45° field of view. Image size 2212x1659. Color fundus photograph — 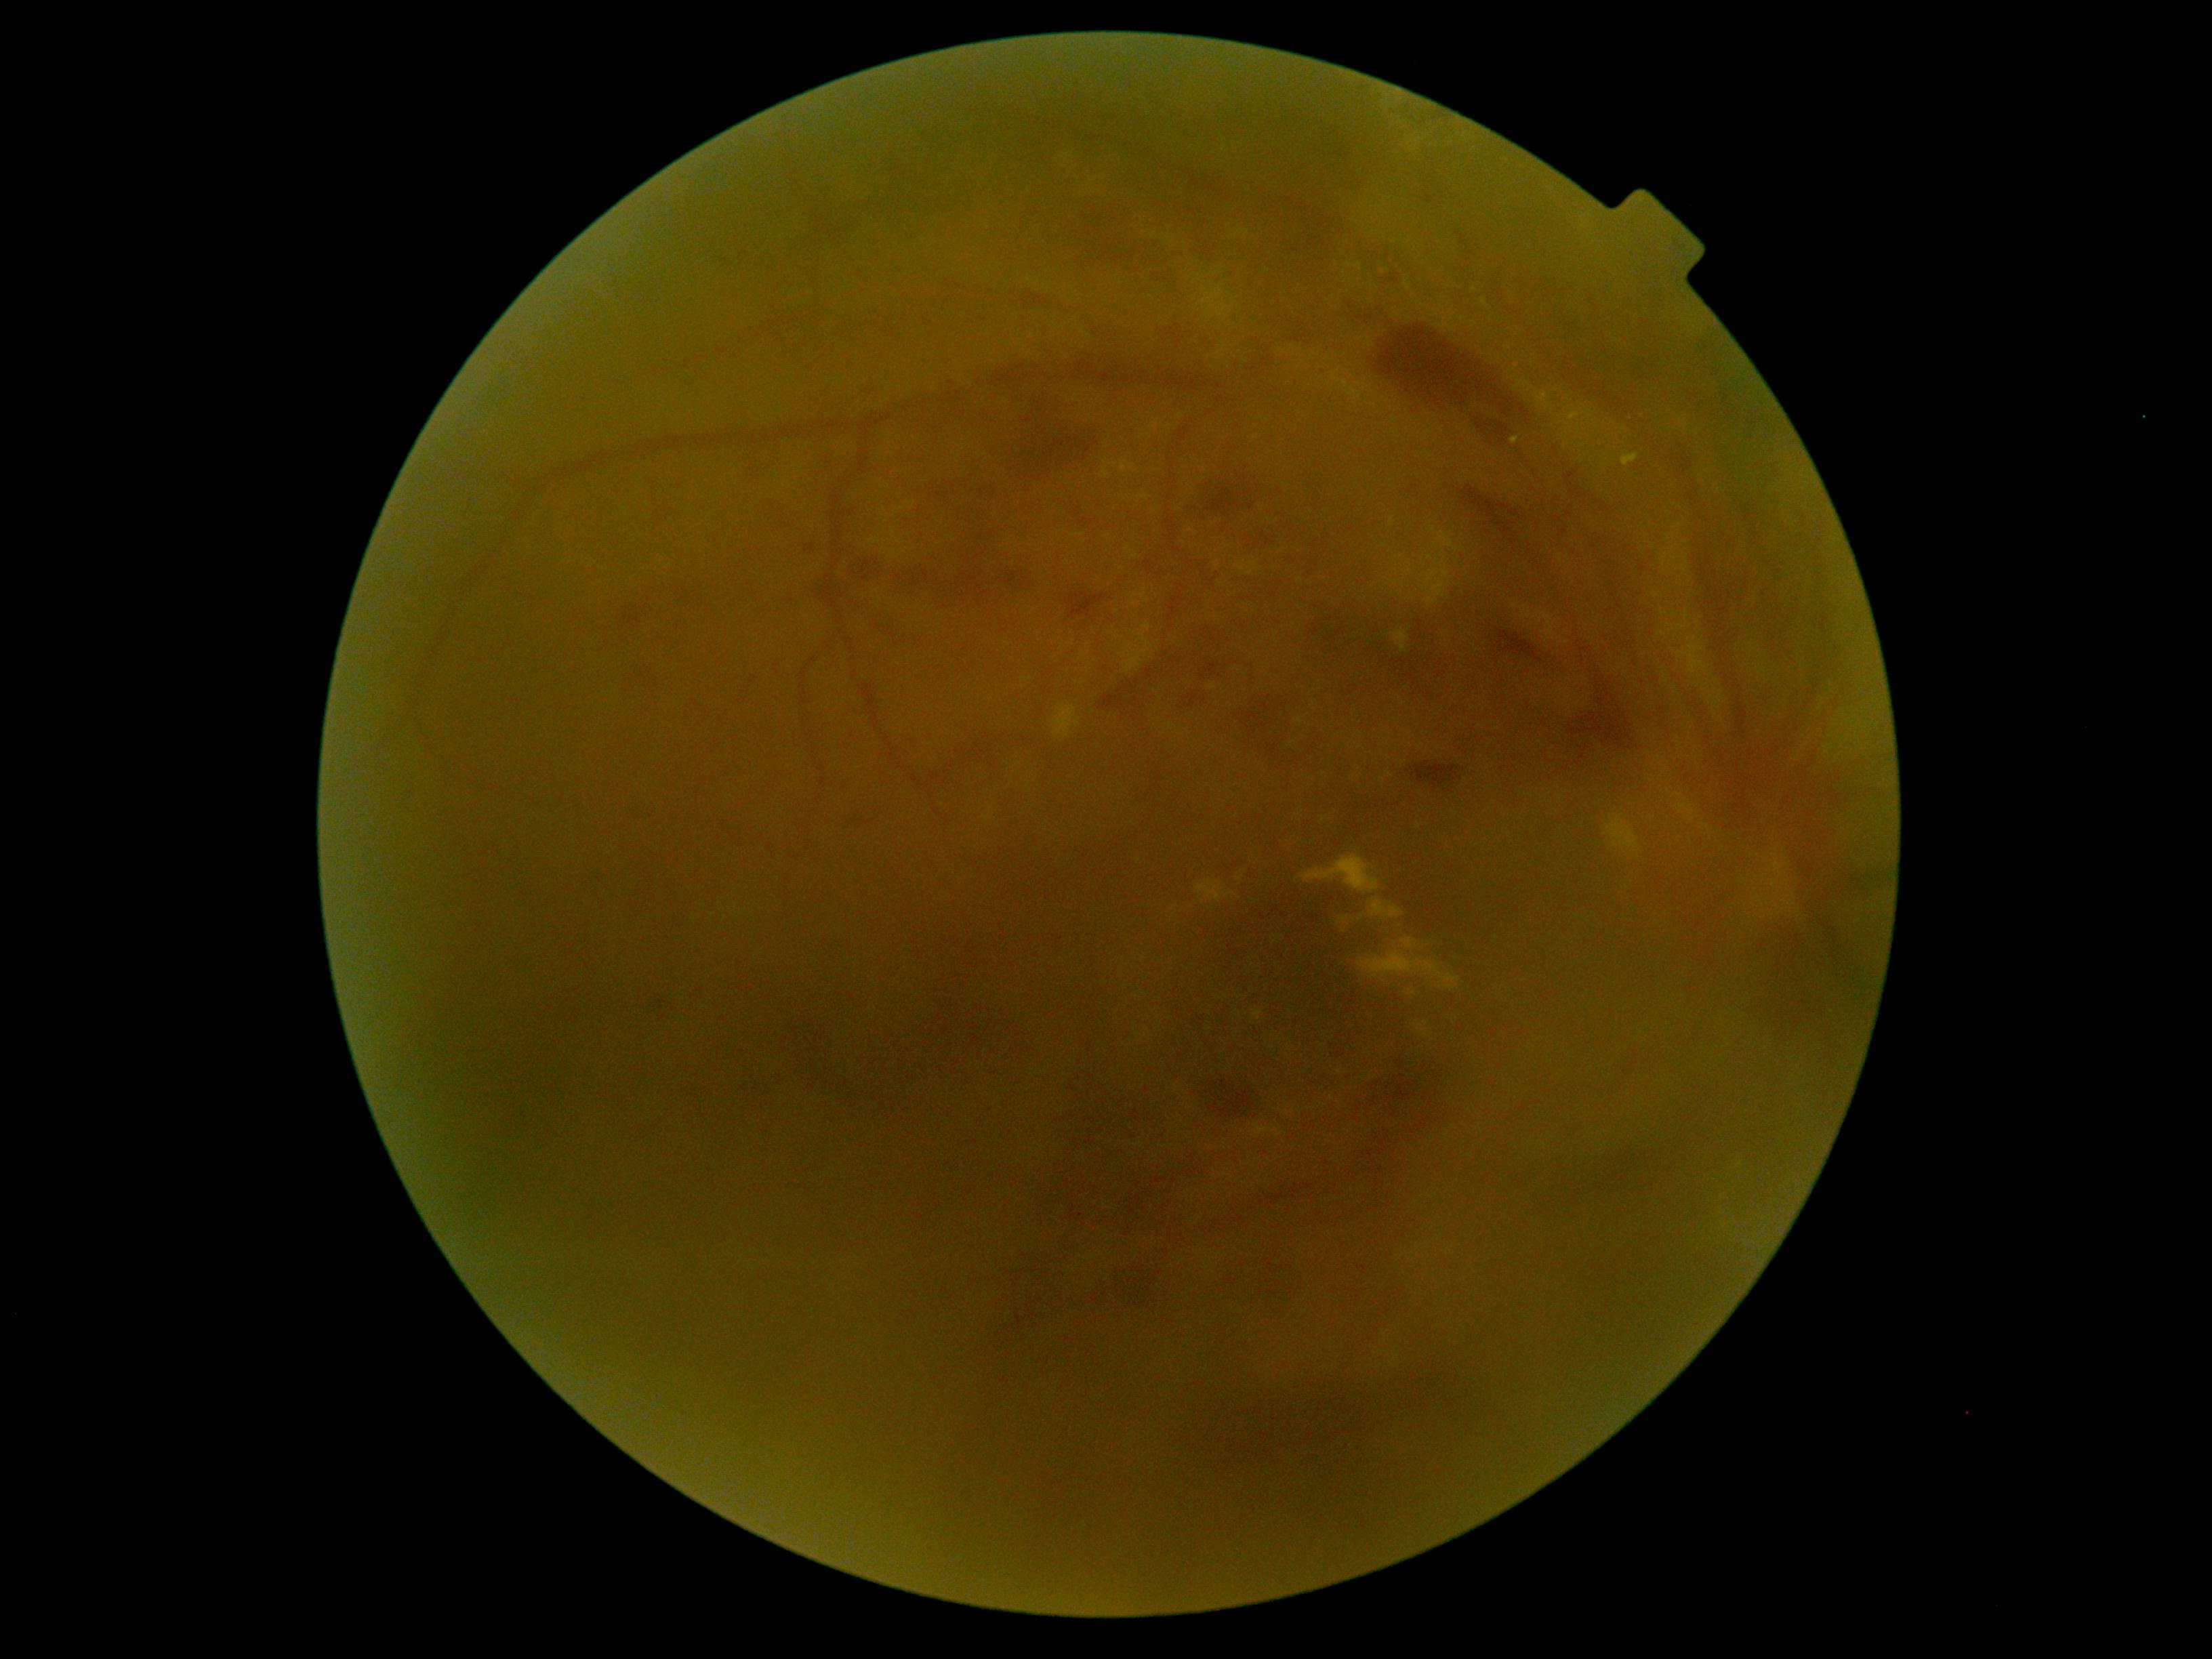

The retinopathy is classified as proliferative diabetic retinopathy. Diabetic retinopathy grade is 4 — neovascularization and/or vitreous/pre-retinal hemorrhage.